Davis DR grading:
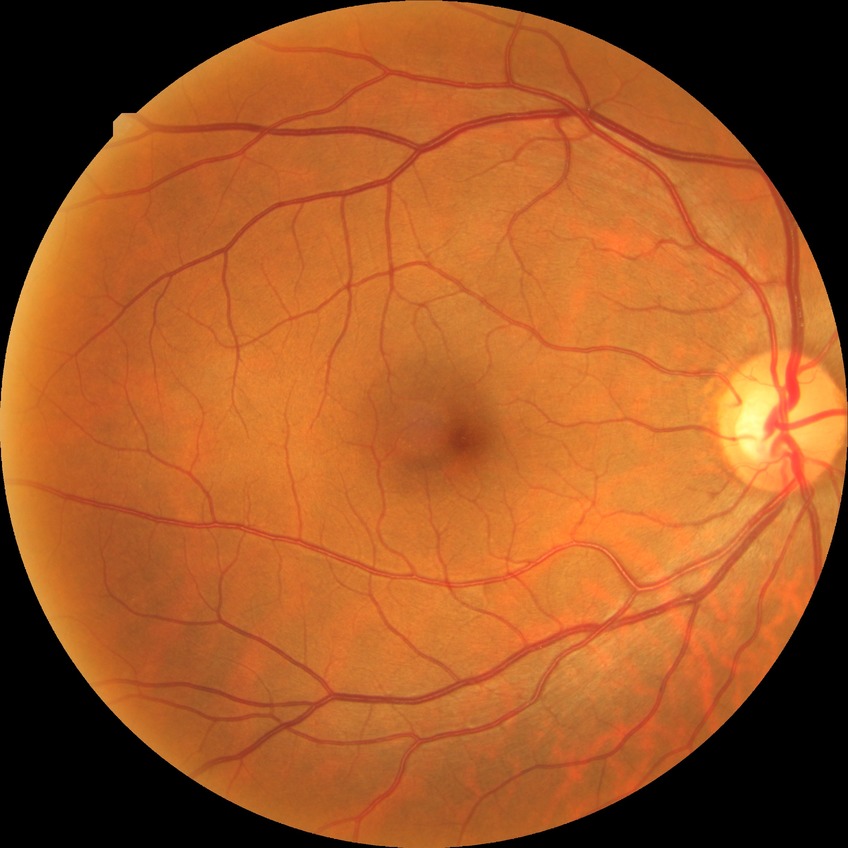

DR grade: NDR.